Woman patient. Non-mydriatic. Refractive error: +0.75 -1 x 150. Retinal fundus photograph. 55 years old: 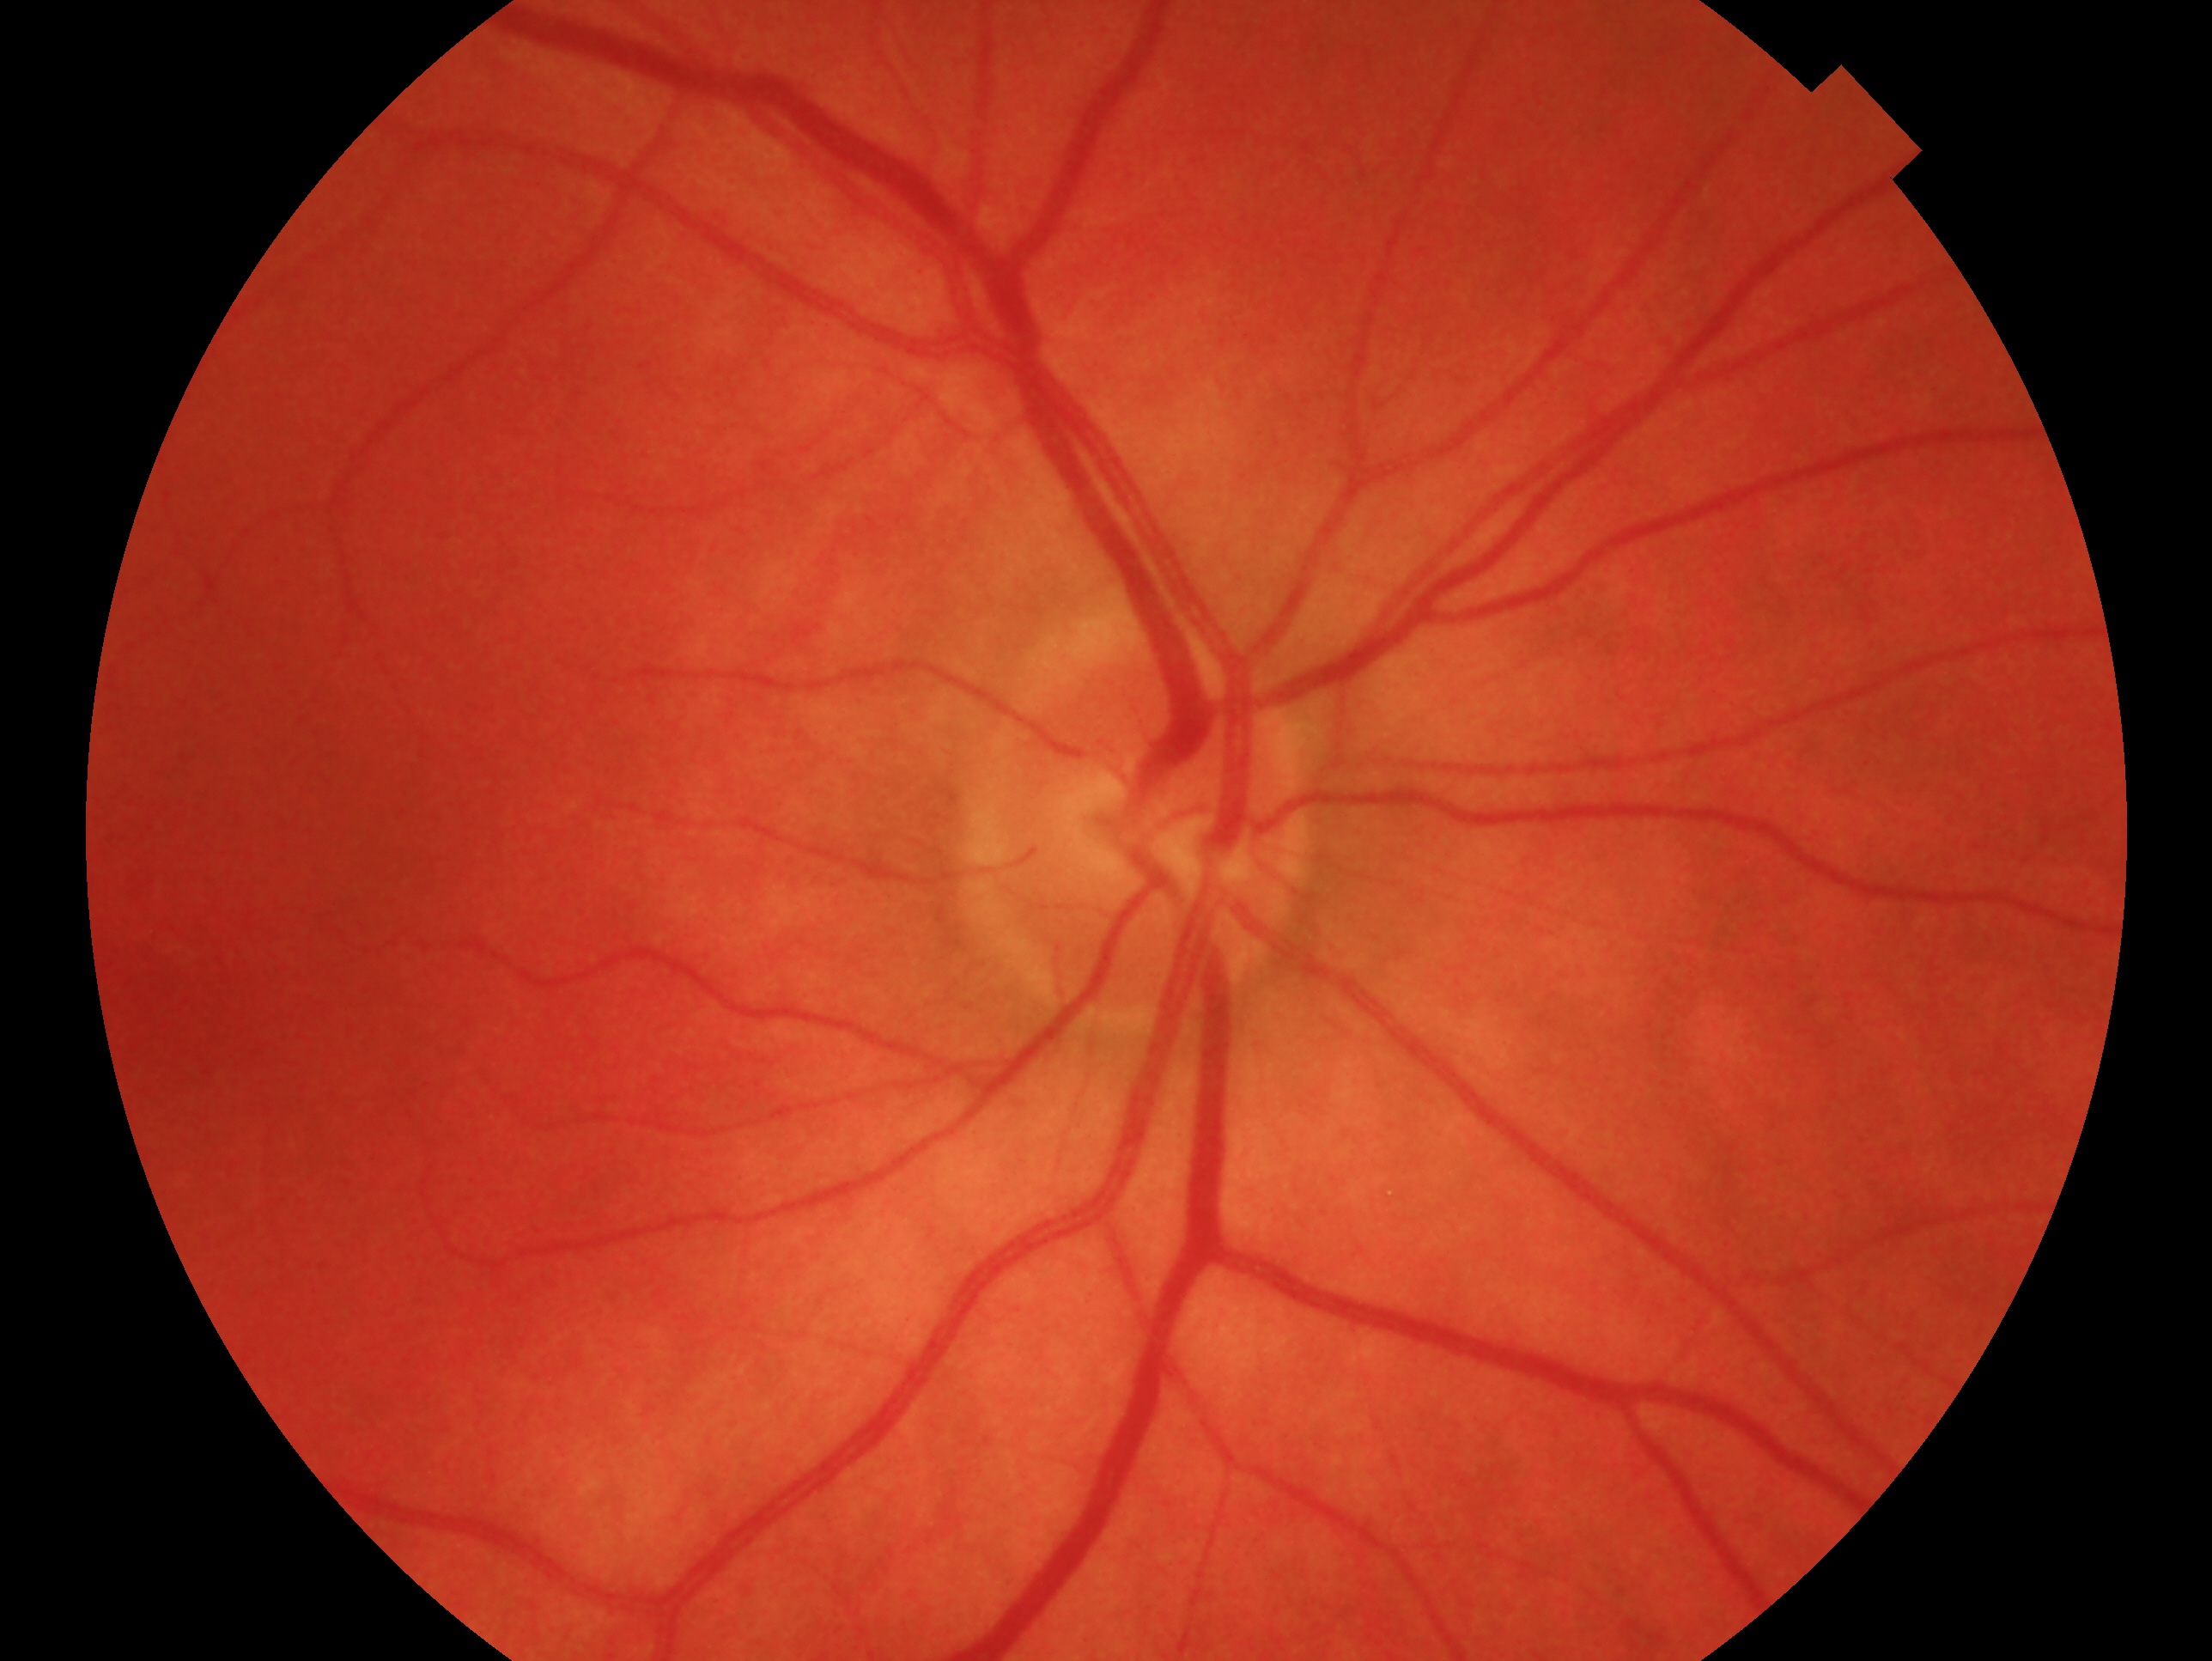 Glaucoma assessment: no evidence of glaucoma — no clinical evidence of glaucoma in this eye.
The image shows the right eye.